2352 x 1568 pixels, fundus photo, 45-degree field of view
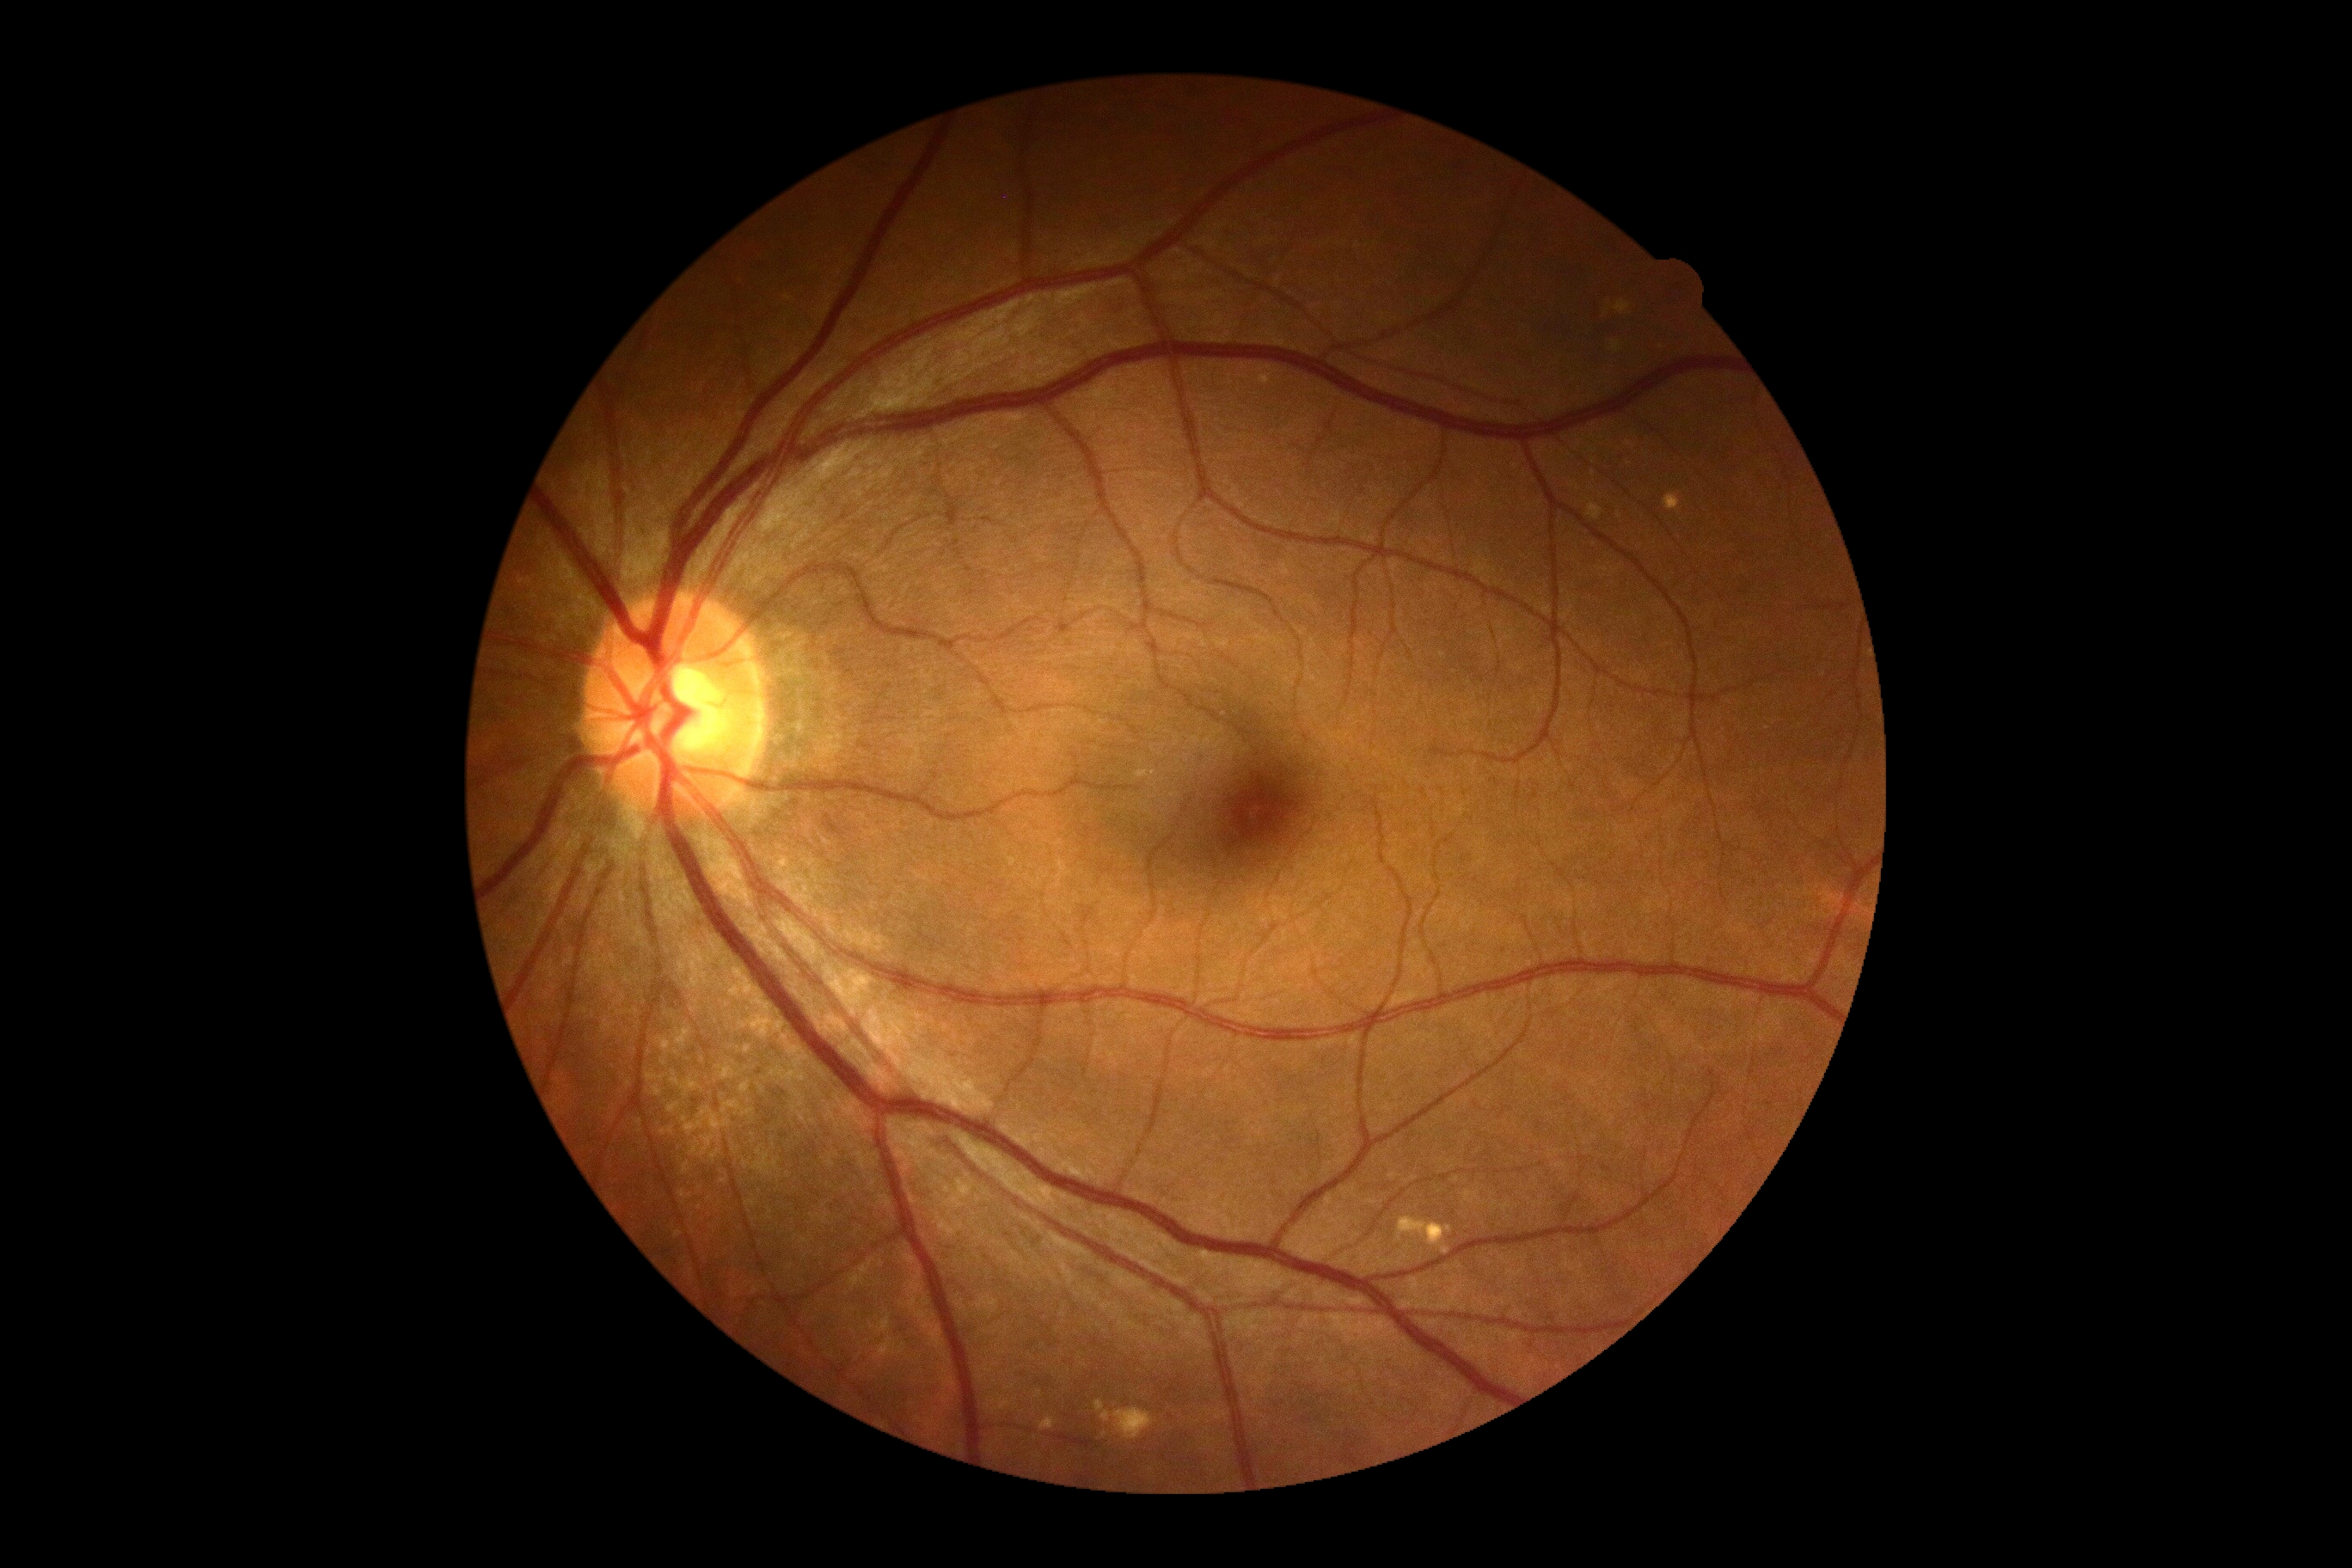 diabetic retinopathy severity = 0.